Remidio smartphone fundus camera.
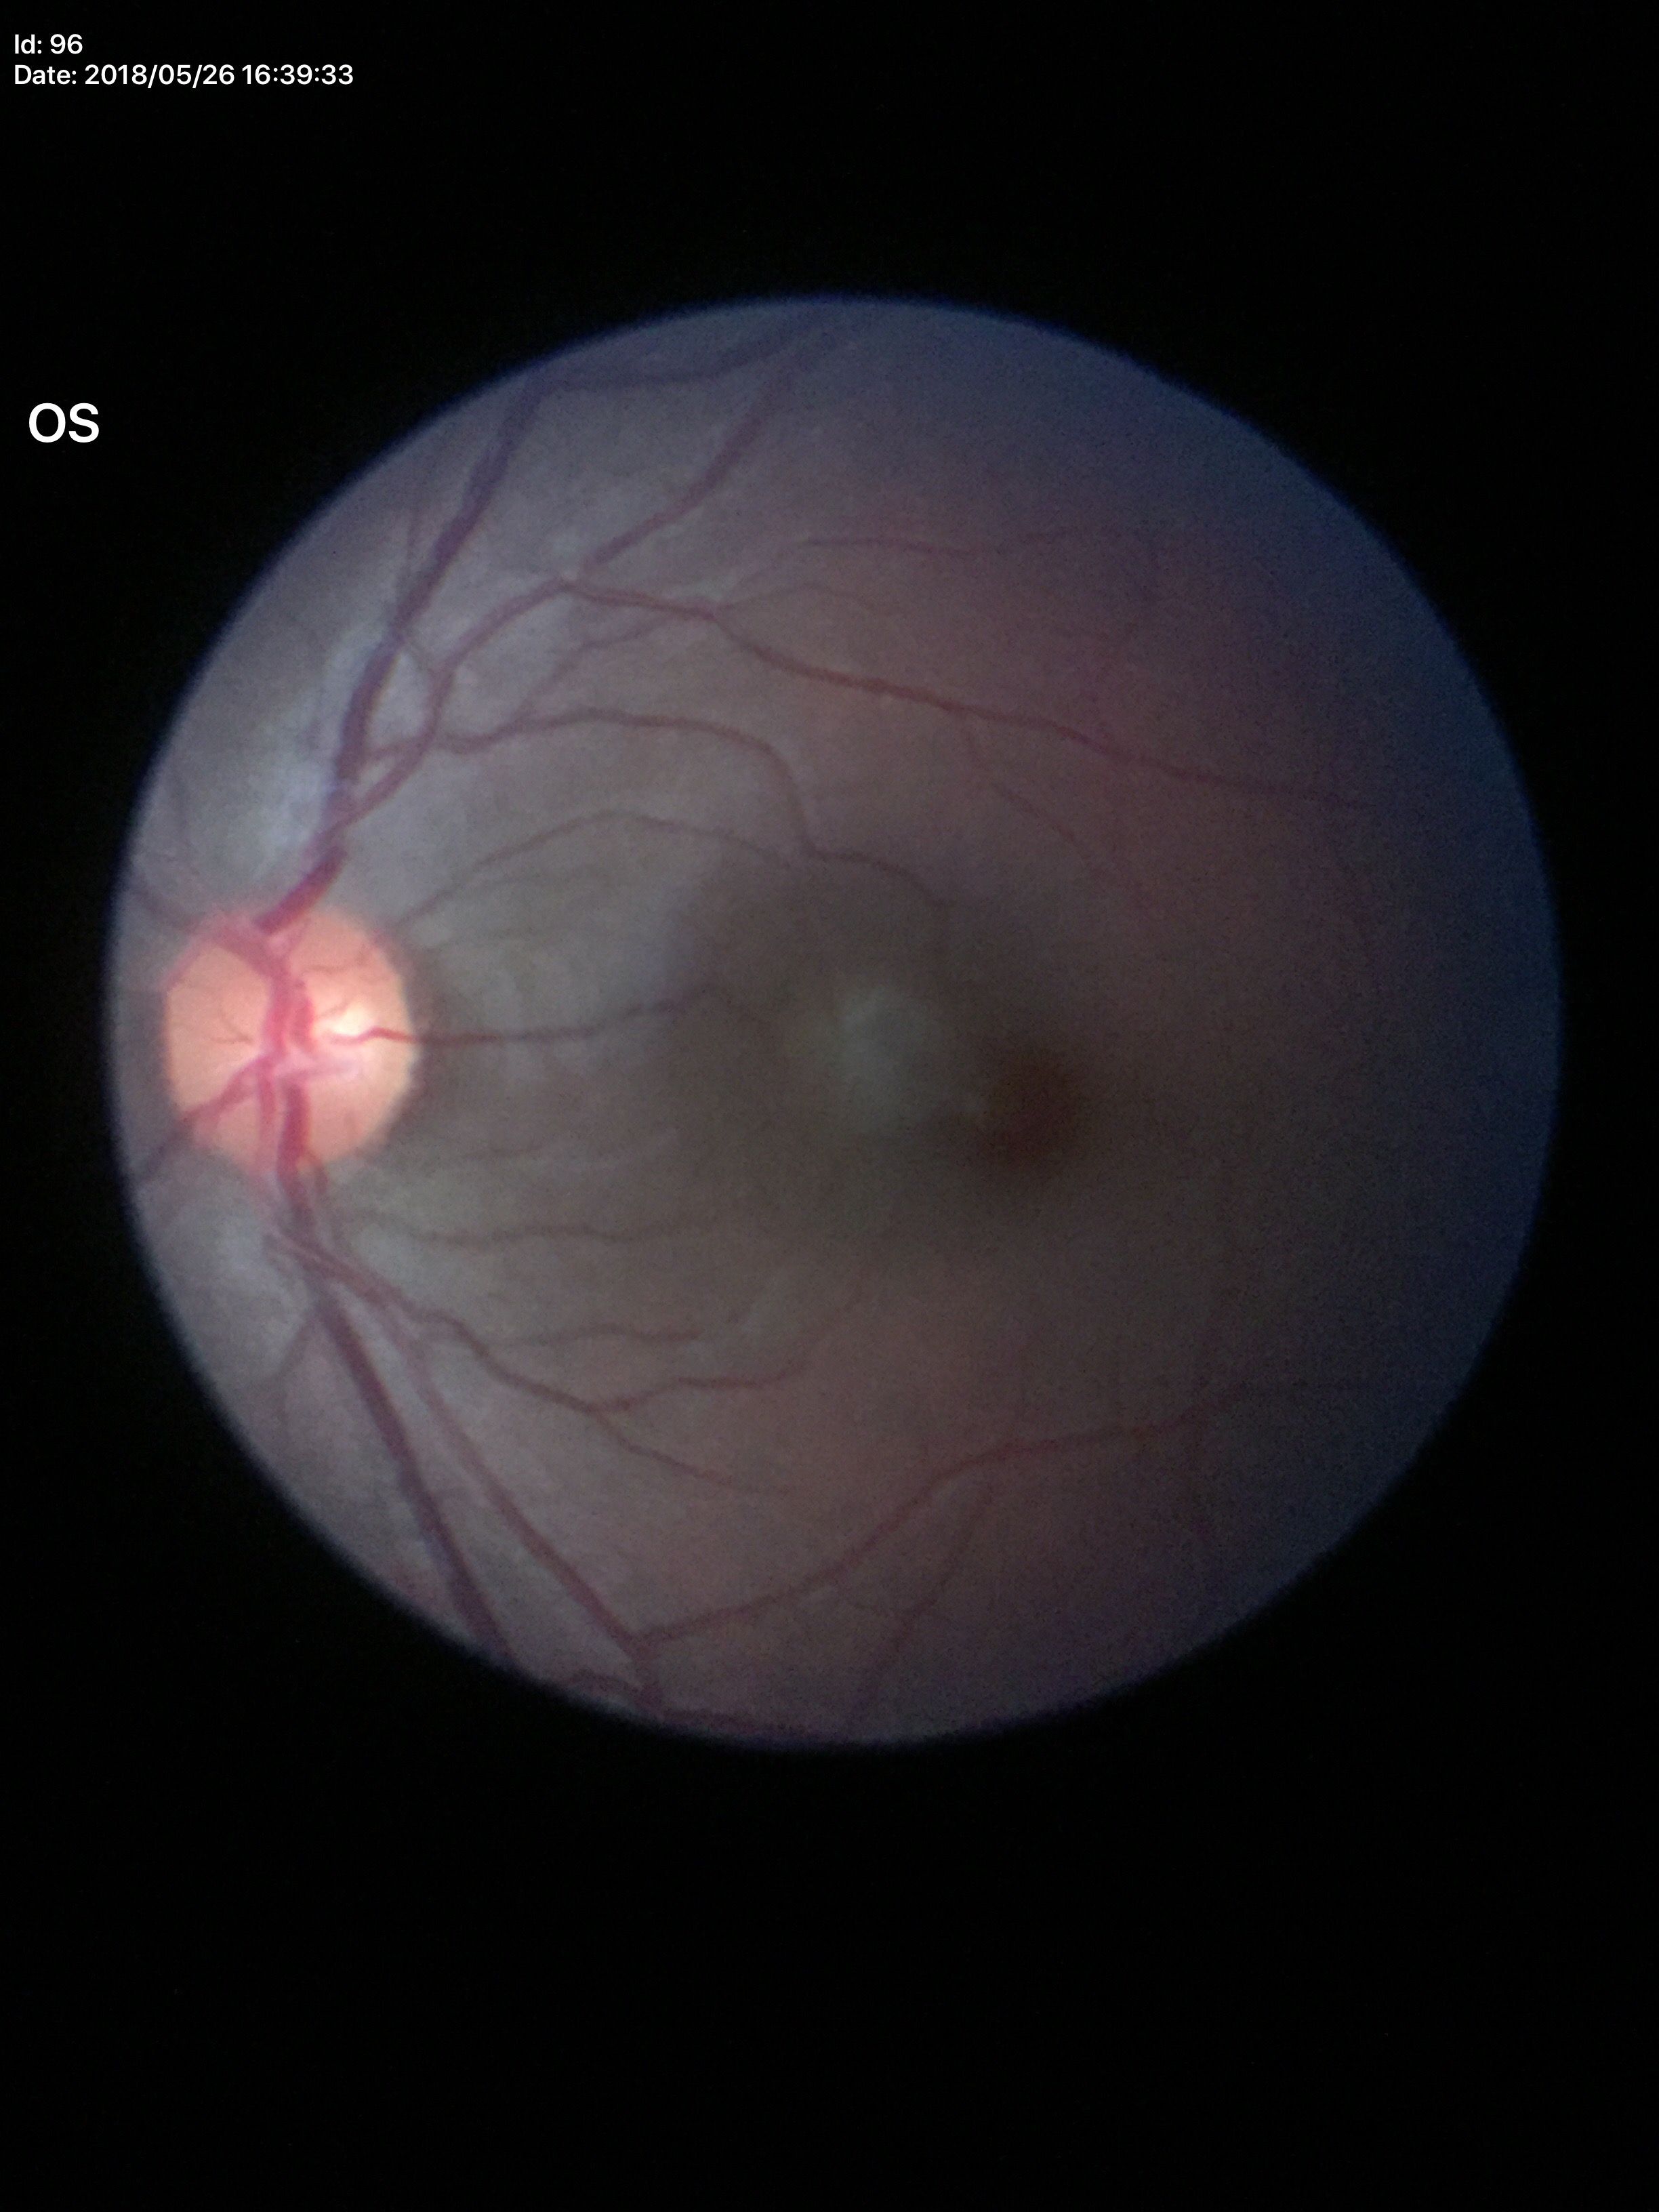 No evidence of glaucoma. Vertical cup-to-disc ratio of 0.49.